640x480 · infant wide-field retinal image:
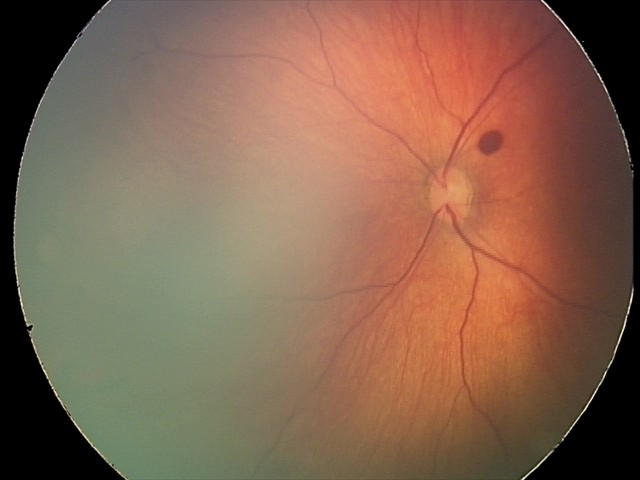 Q: What is the screening diagnosis?
A: retinal hemorrhages